Camera: NIDEK AFC-230; Davis DR grading; nonmydriatic fundus photograph — 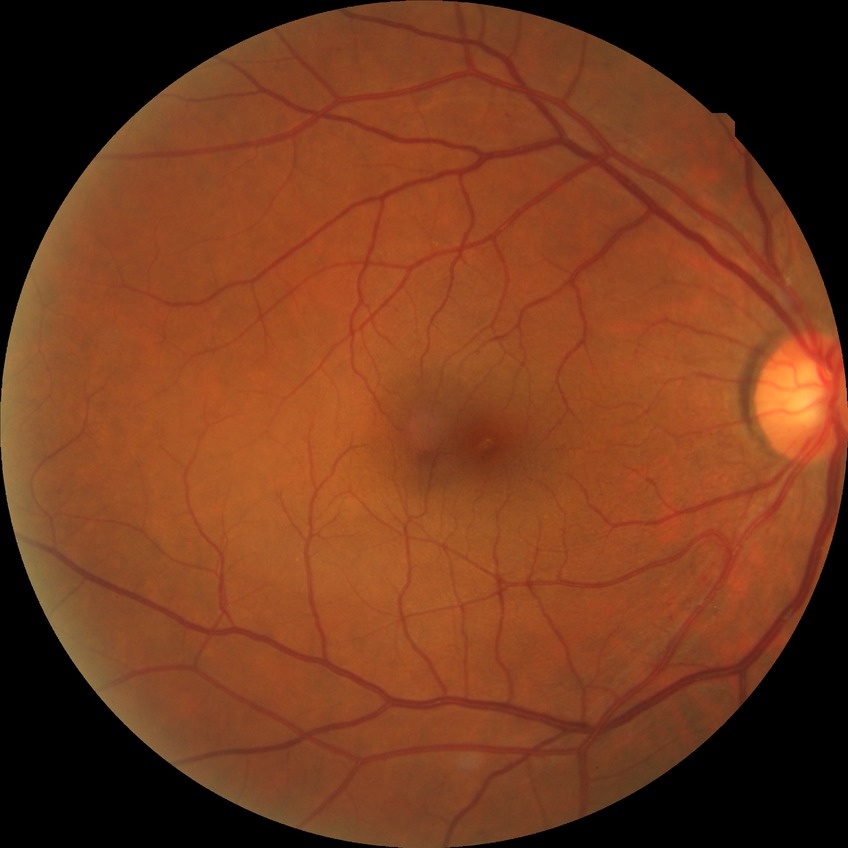
Diabetic retinopathy grade is simple diabetic retinopathy.